848x848
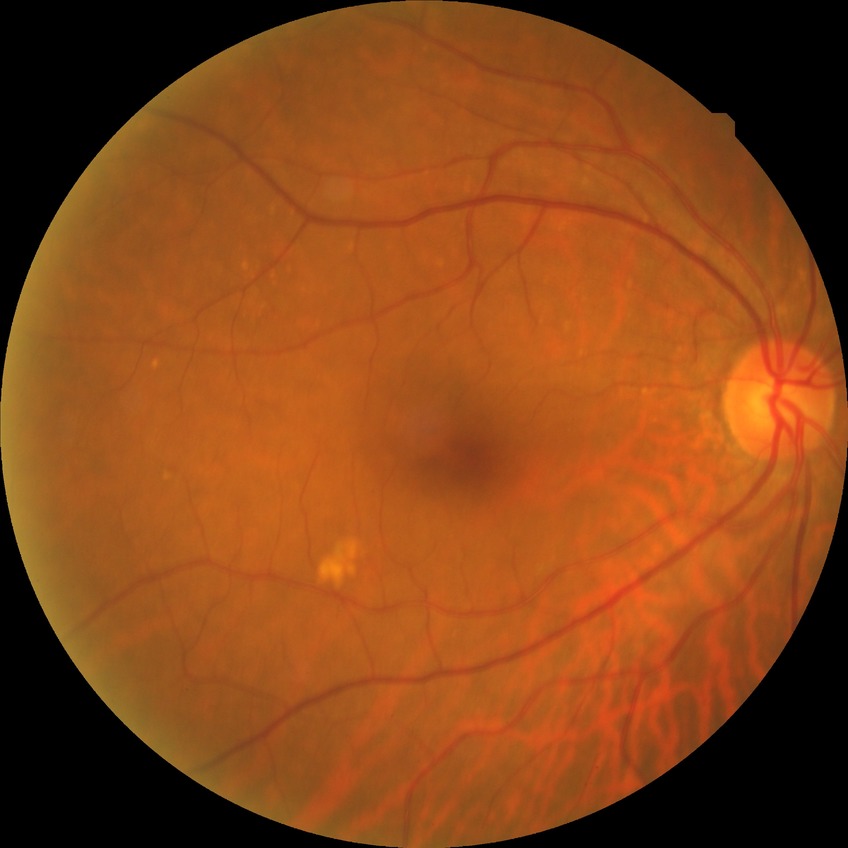 Assessment:
• diabetic retinopathy (DR): no diabetic retinopathy (NDR)